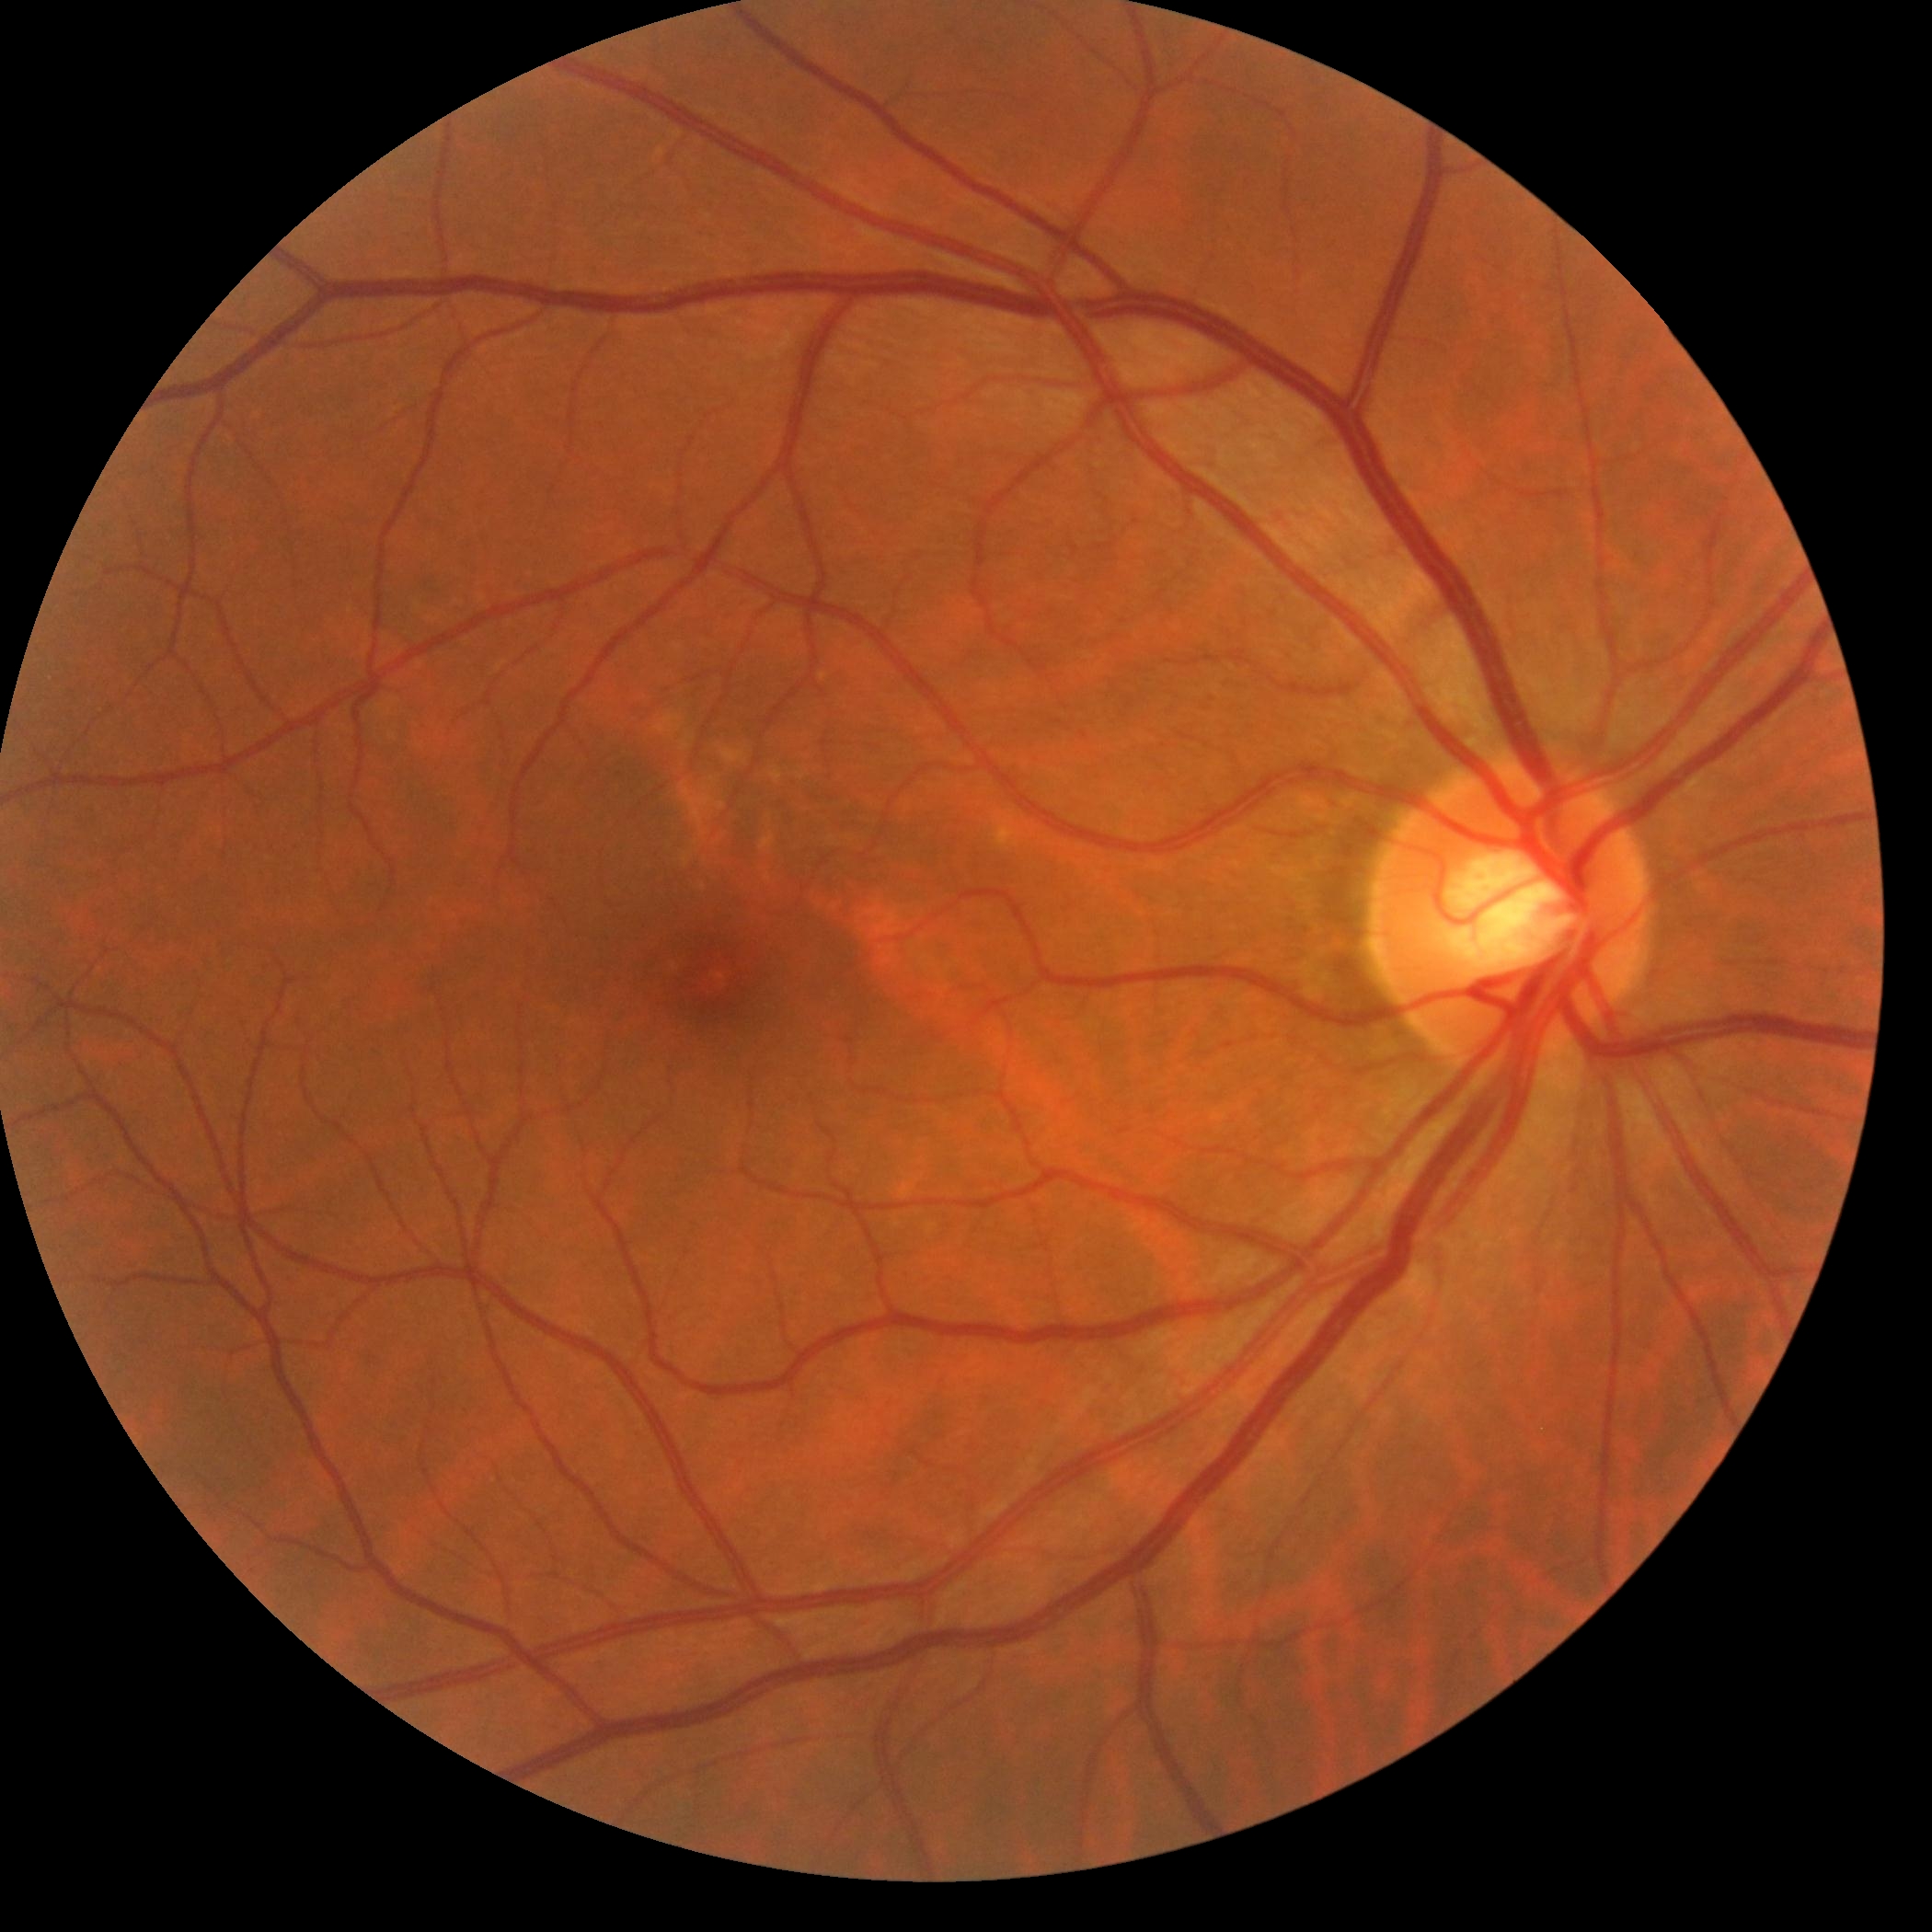
diabetic retinopathy=grade 0 (no apparent retinopathy).